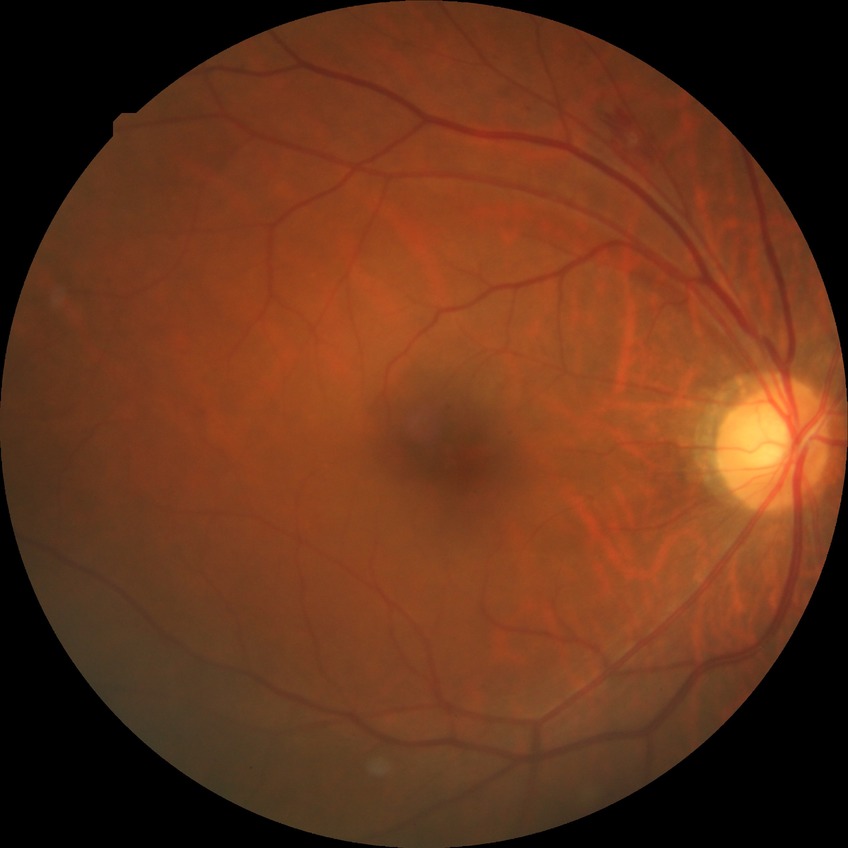

DR grade: SDR. The retinopathy is classified as non-proliferative diabetic retinopathy.